Camera: NIDEK AFC-230.
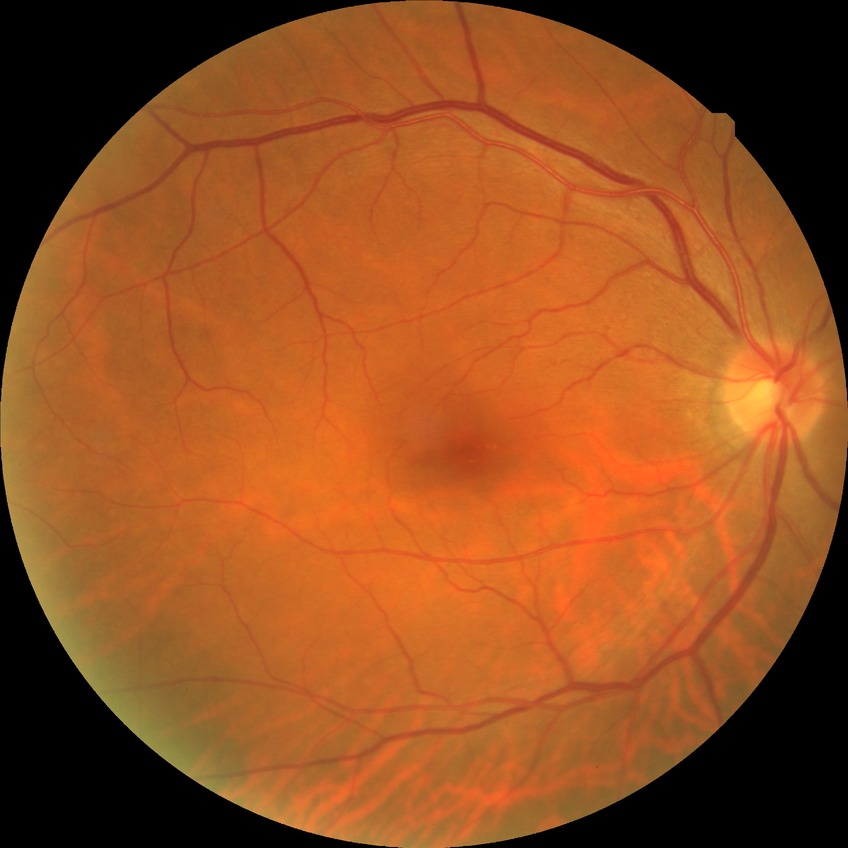 DR severity is NDR.
No DR findings.